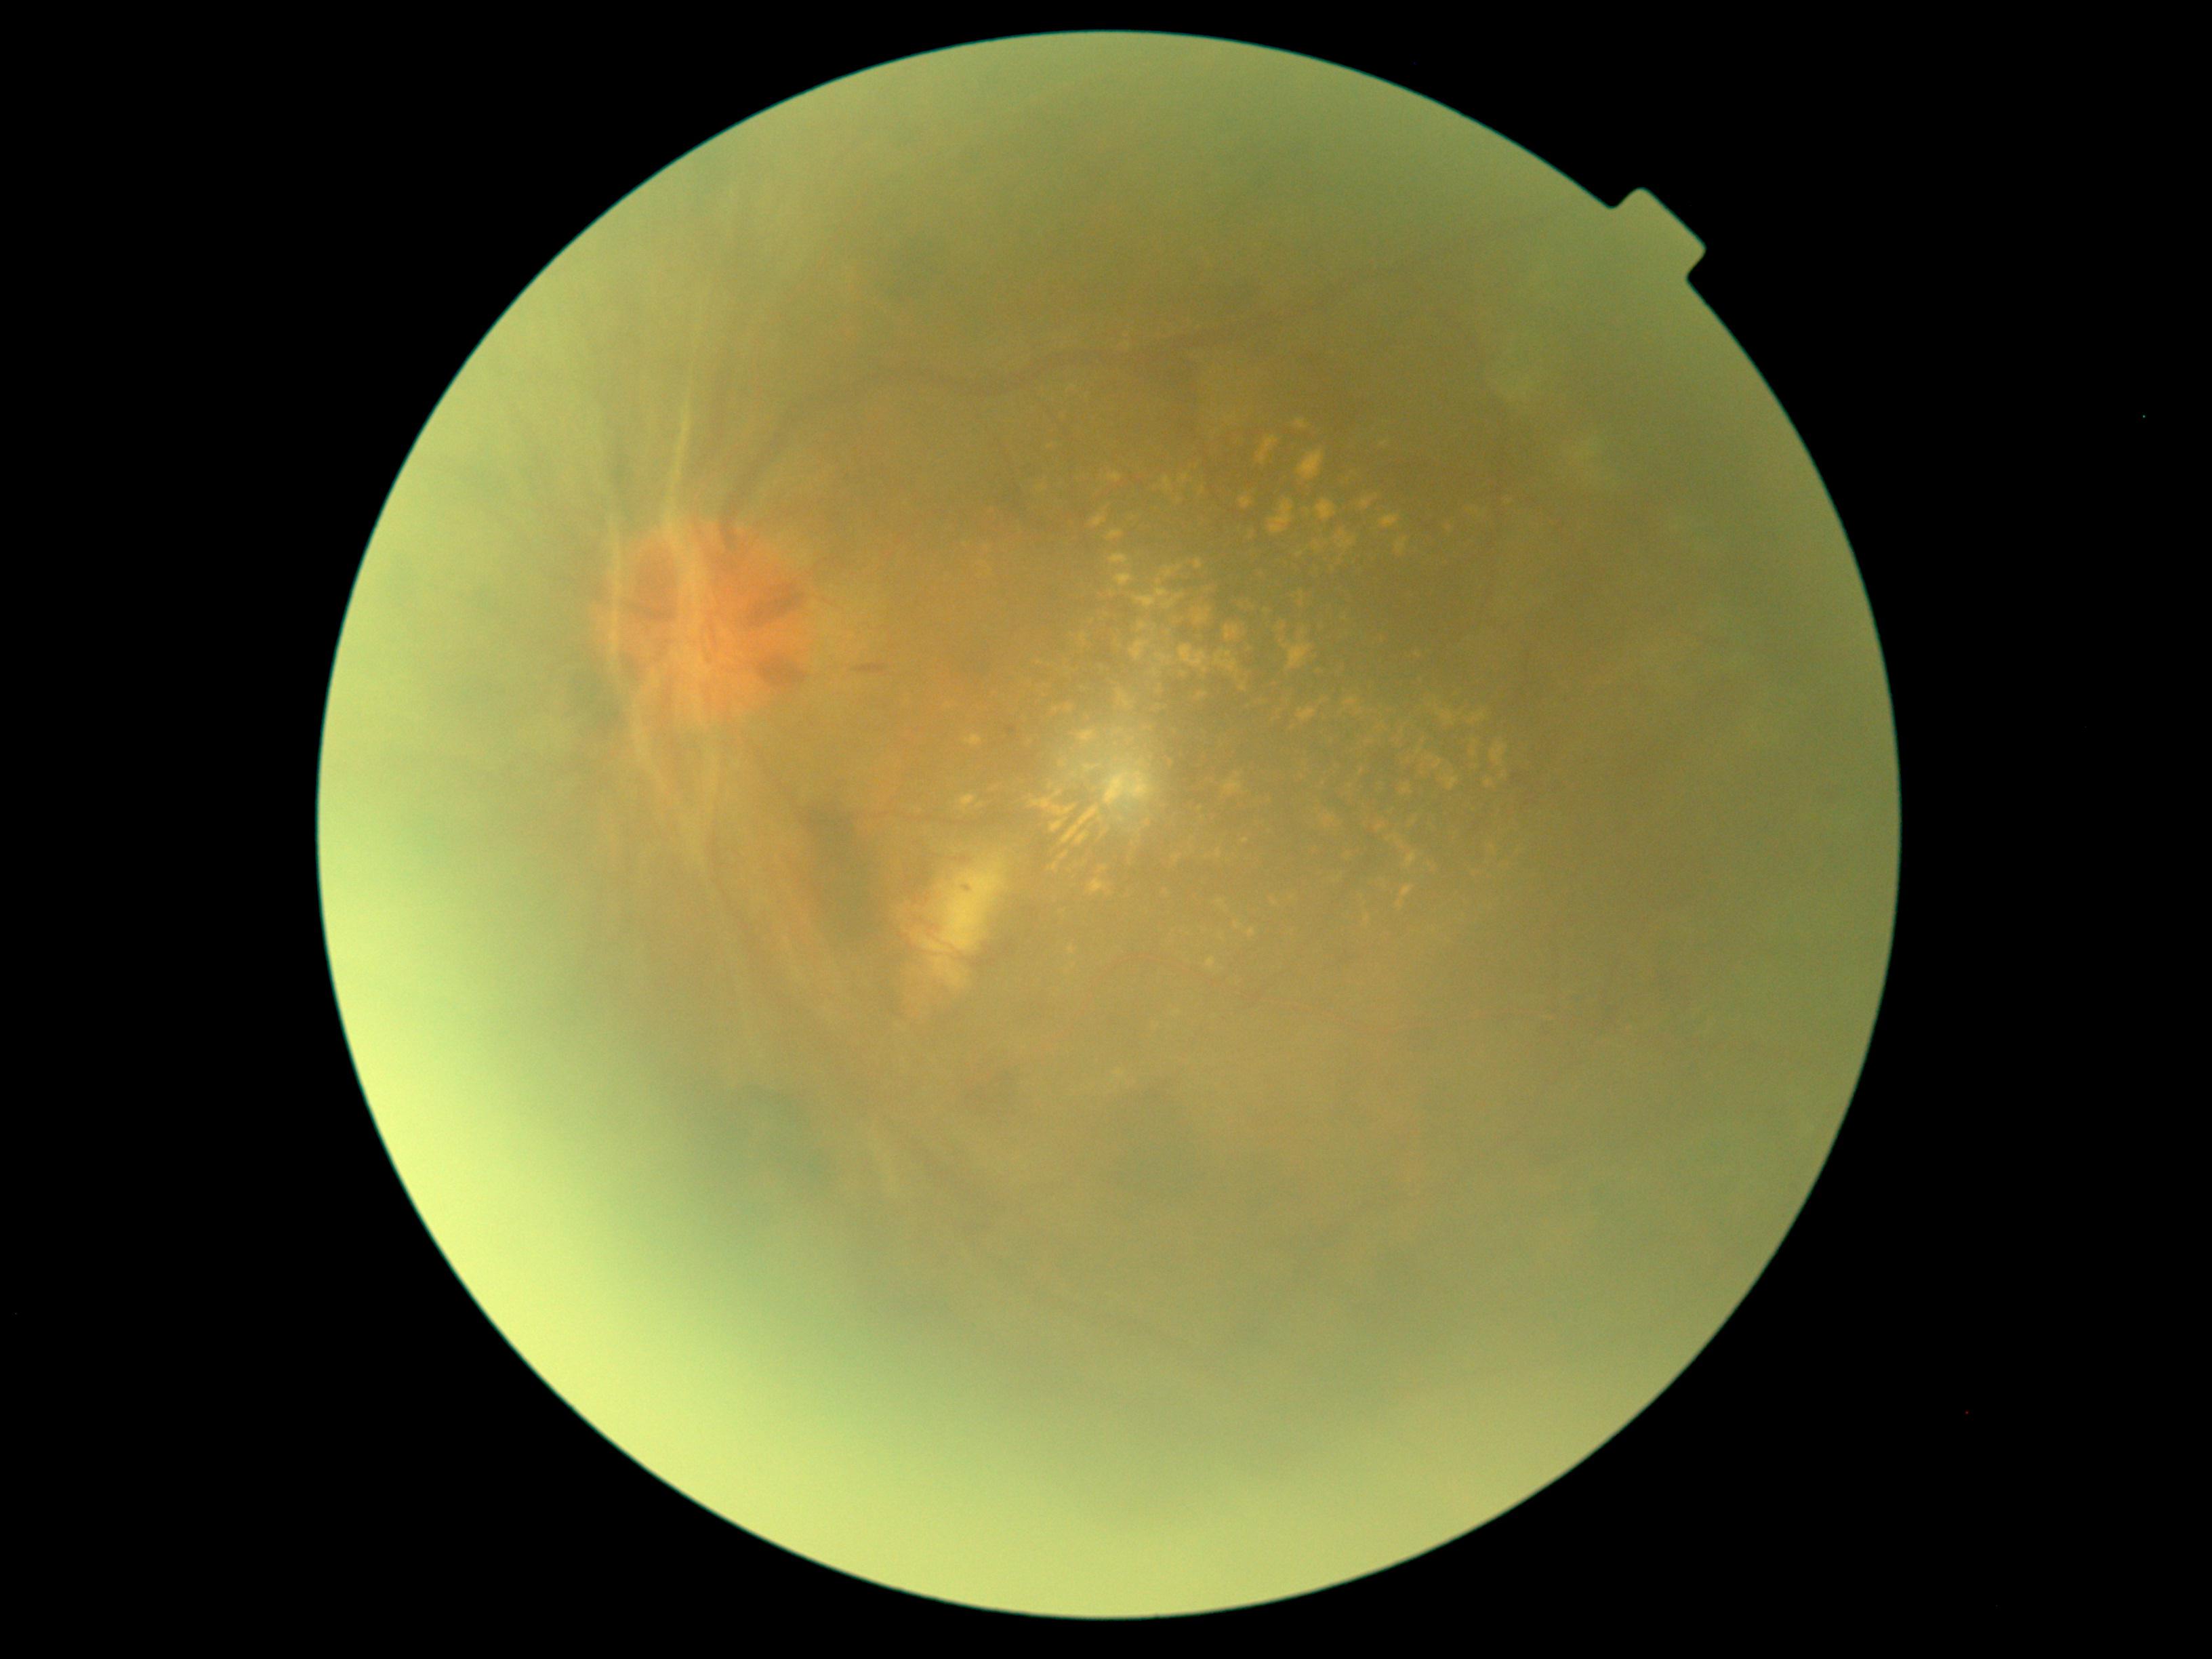
  dr_grade: PDR (grade 4)
  dr_category: proliferative diabetic retinopathy